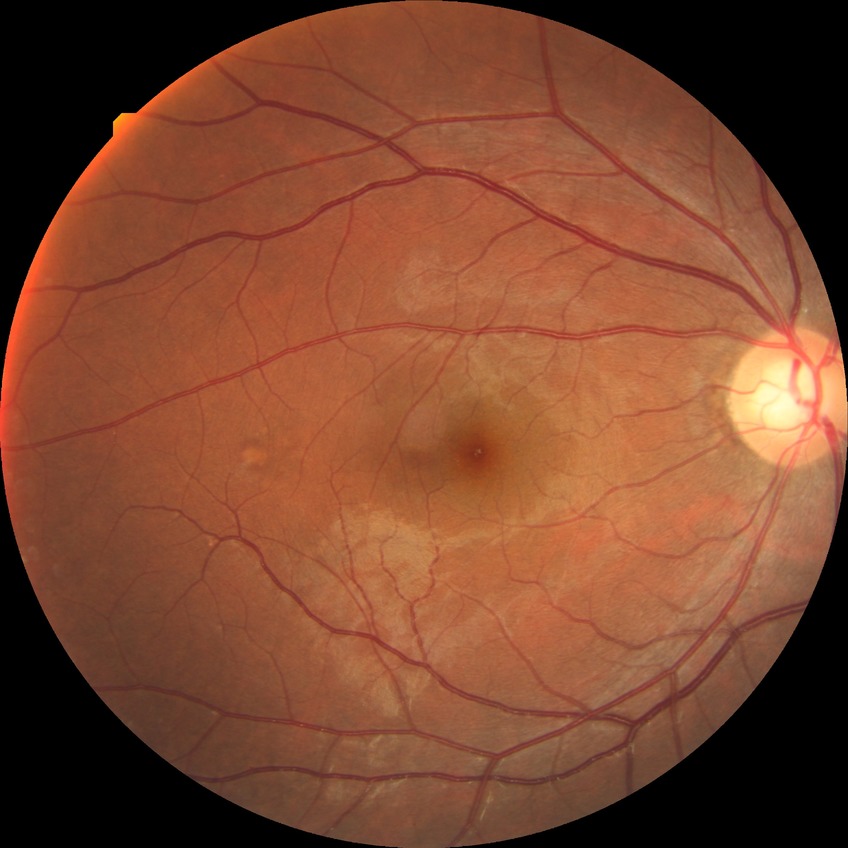
Davis grade = NDR